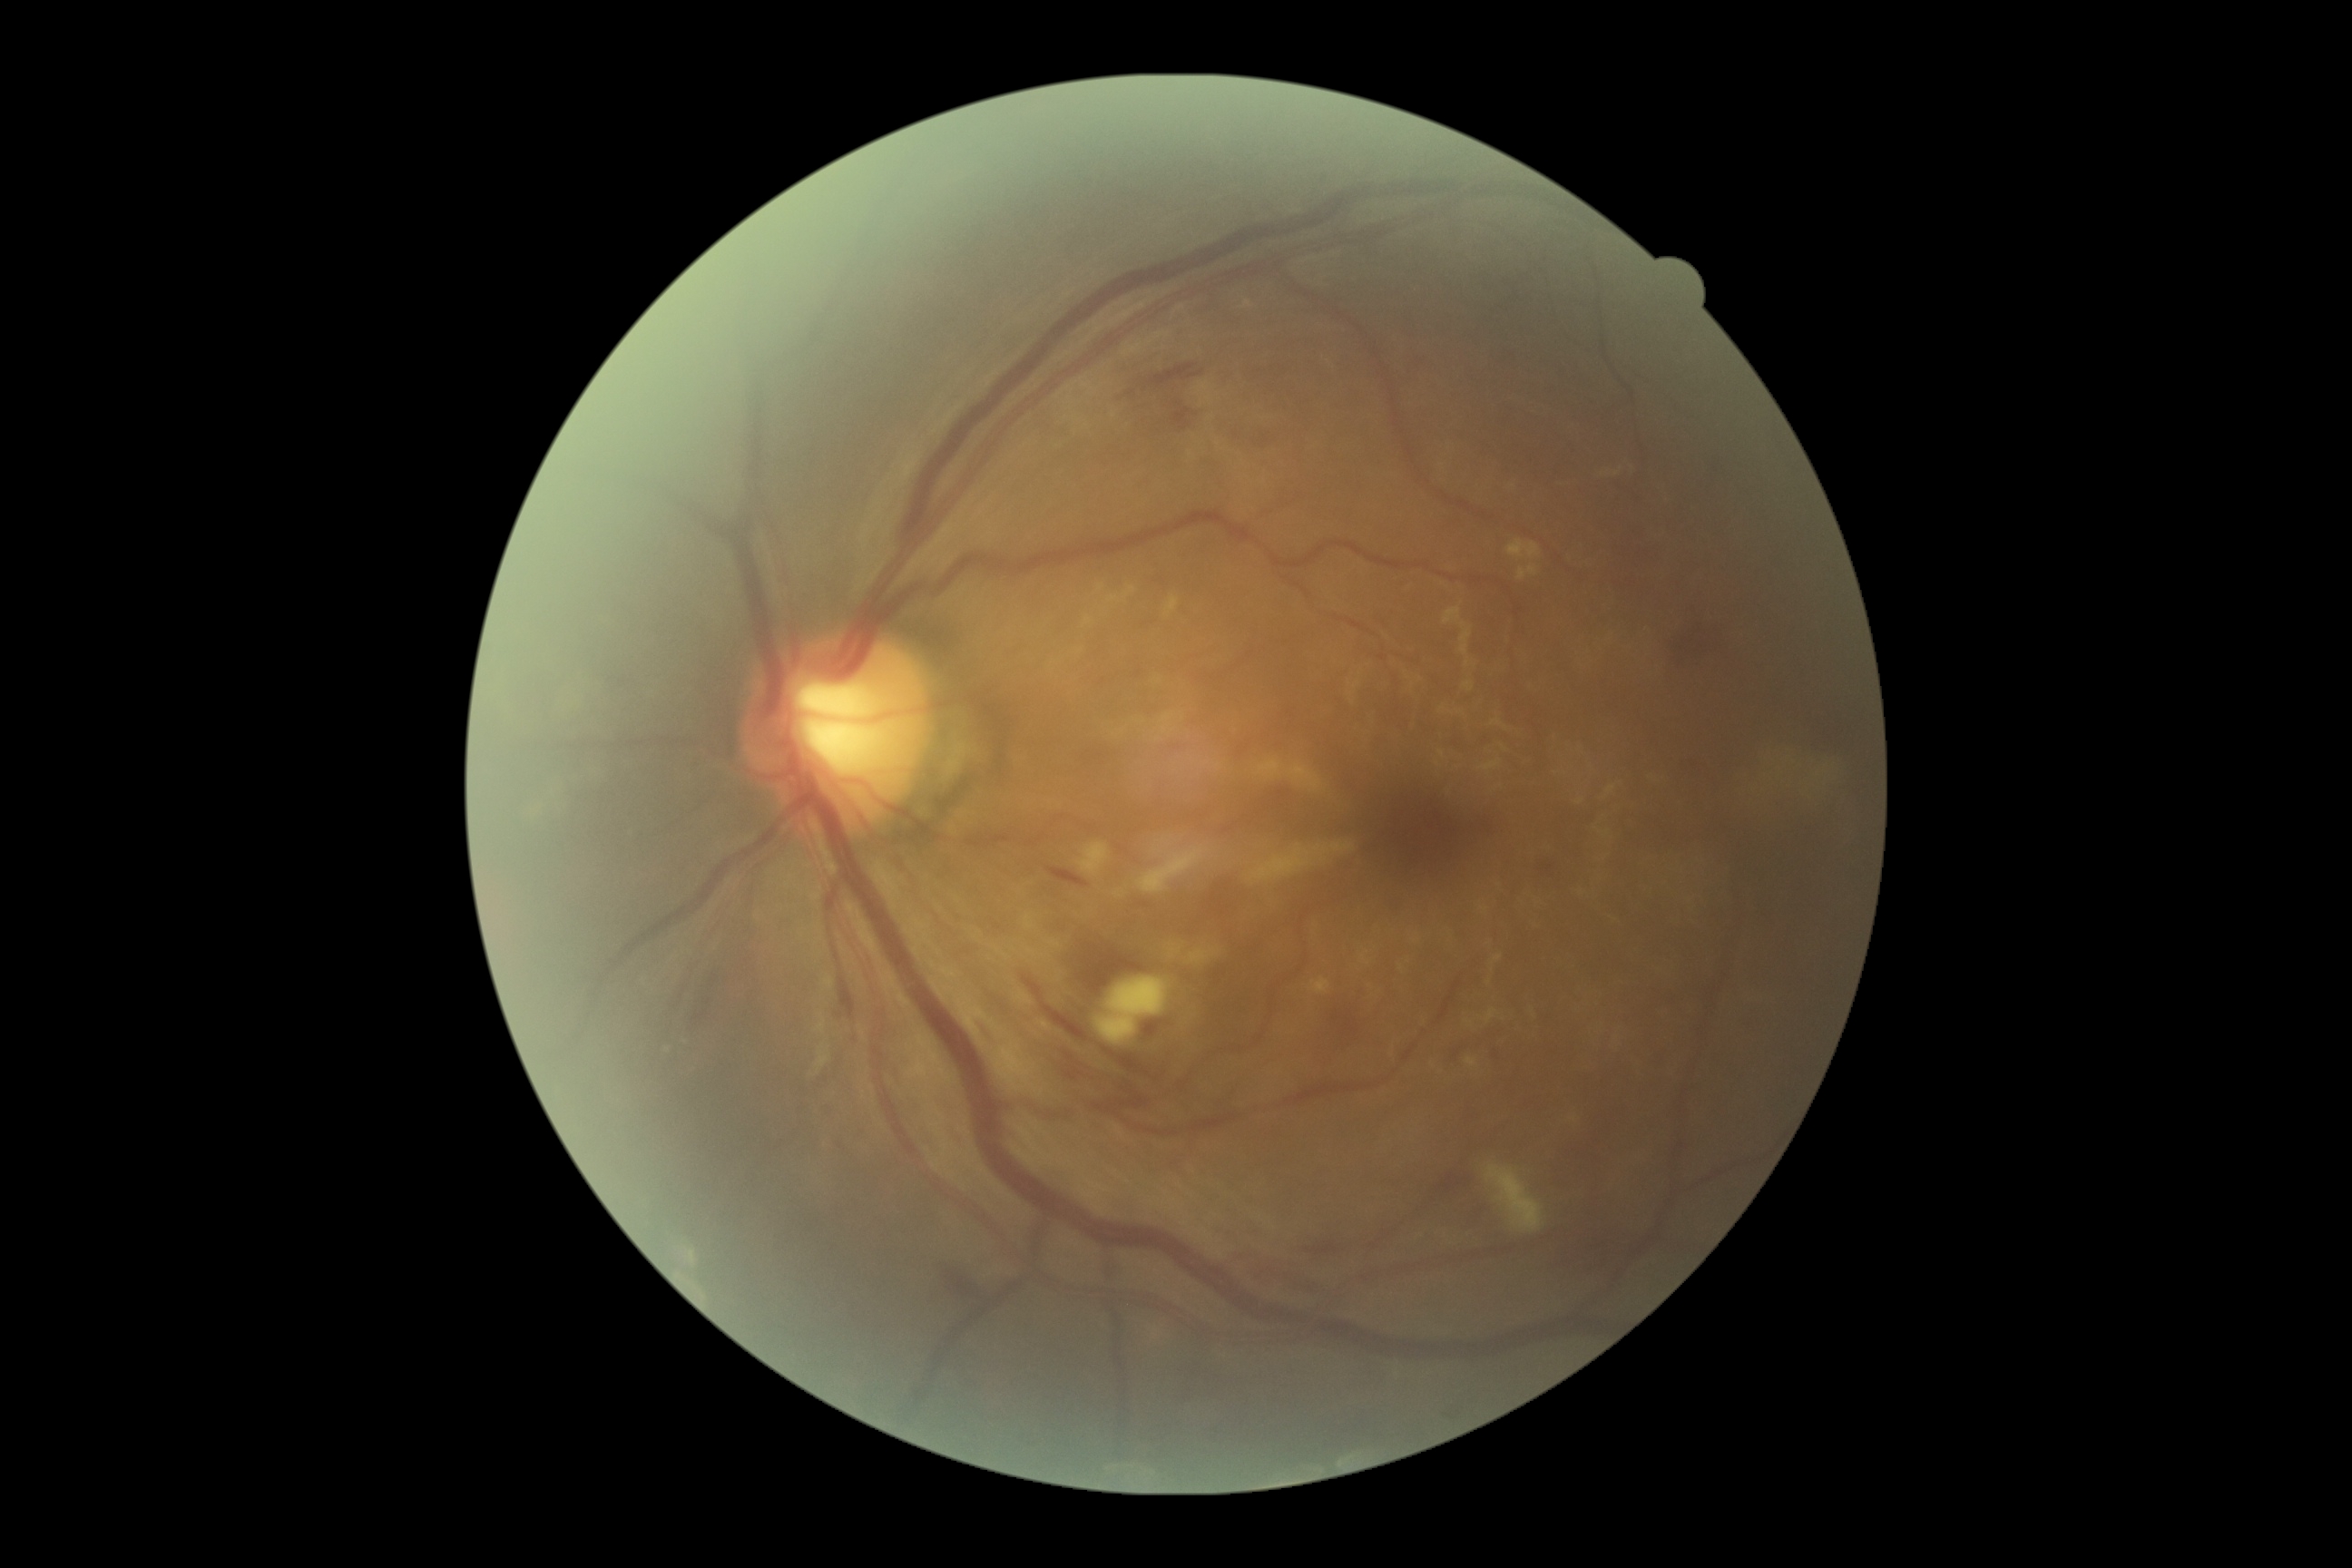 DR stage: 2/4 | DR class: non-proliferative diabetic retinopathy.